Camera: Natus RetCam Envision (130° FOV) · wide-field fundus photograph of an infant.
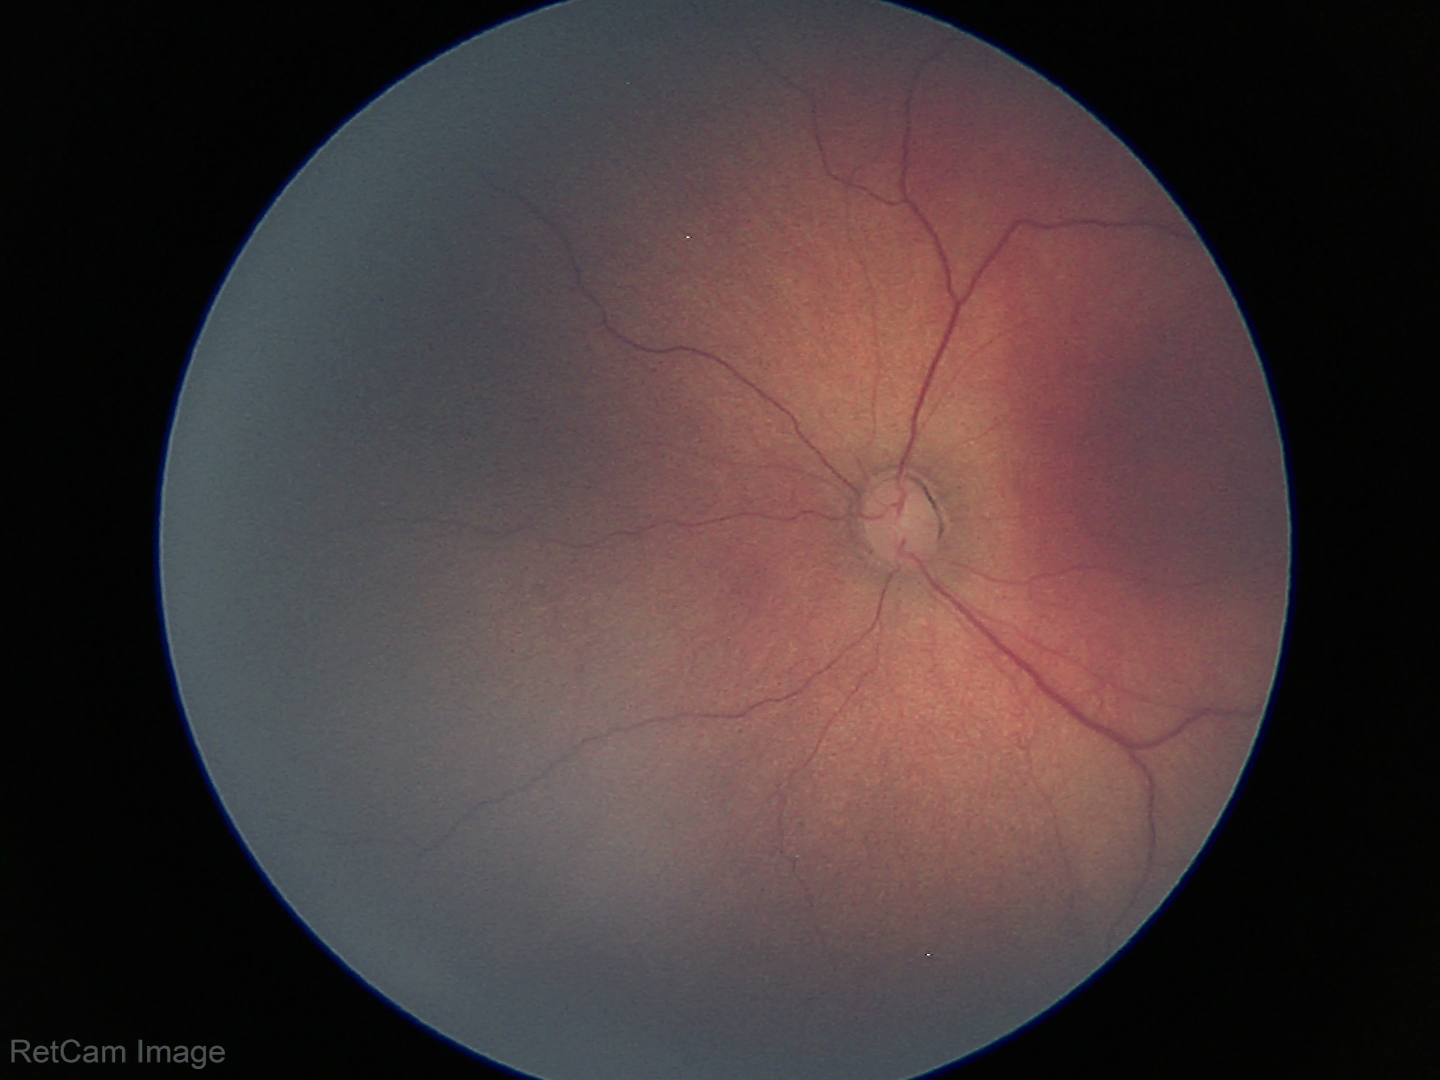 Screening diagnosis: no plus disease; ROP stage 3.